Nonmydriatic fundus photograph · camera: NIDEK AFC-230 · CFP · 45° FOV: 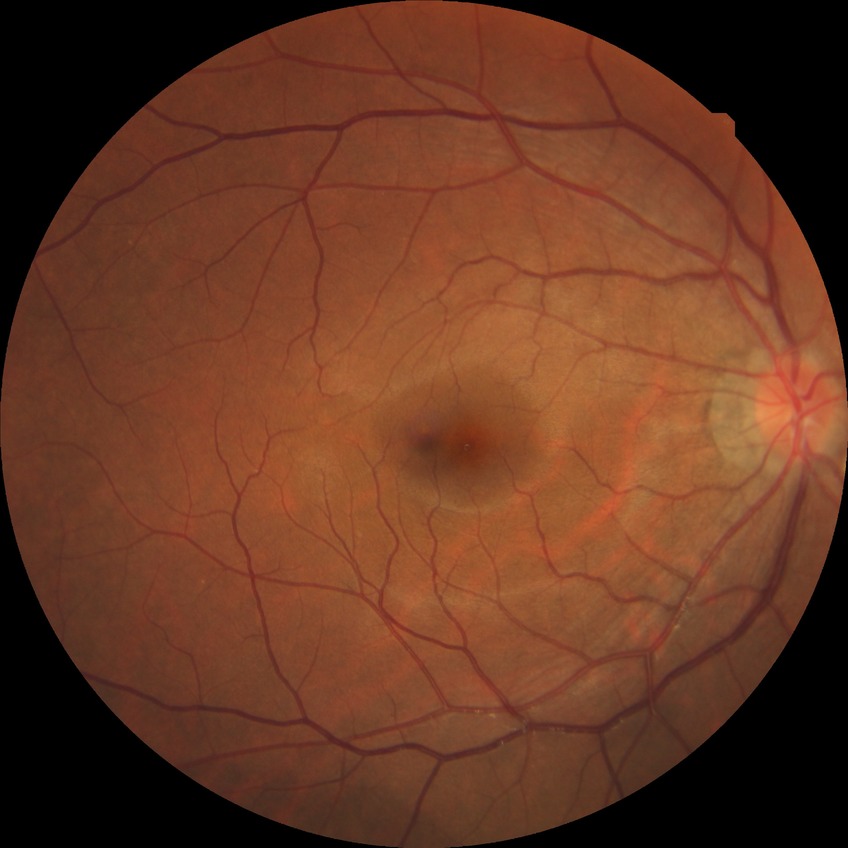

Davis grading = no diabetic retinopathy.